Color fundus photograph. 45-degree field of view:
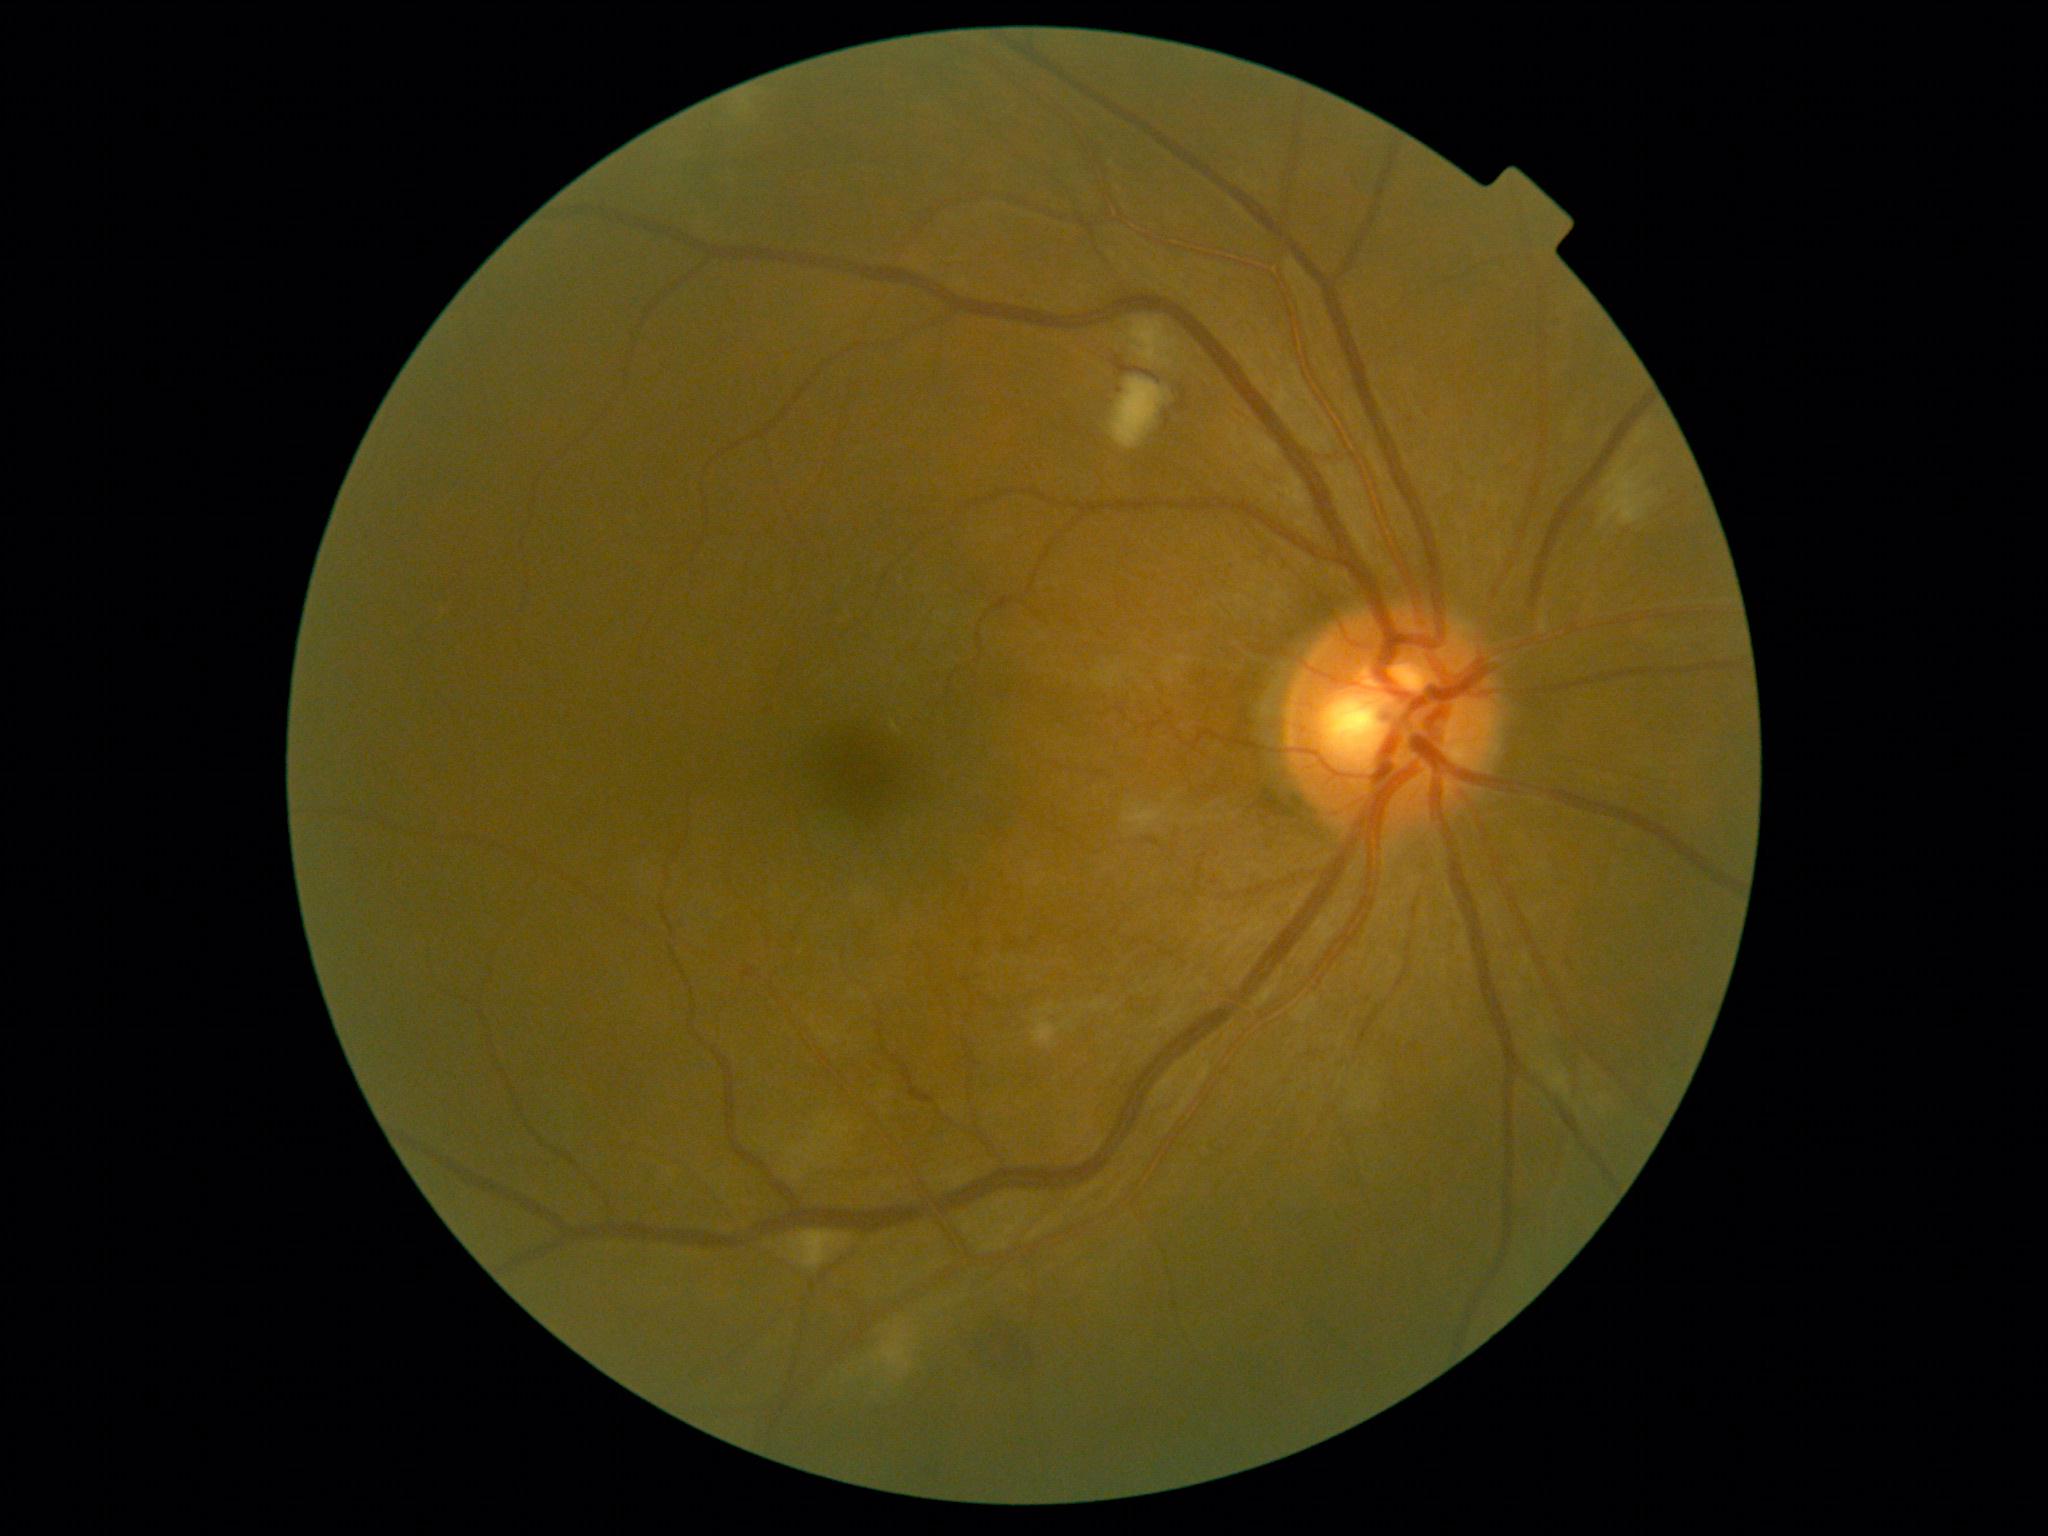

  dr_category: non-proliferative diabetic retinopathy
  dr_grade: 2/4